Camera: Natus RetCam Envision (130° FOV) · wide-field contact fundus photograph of an infant.
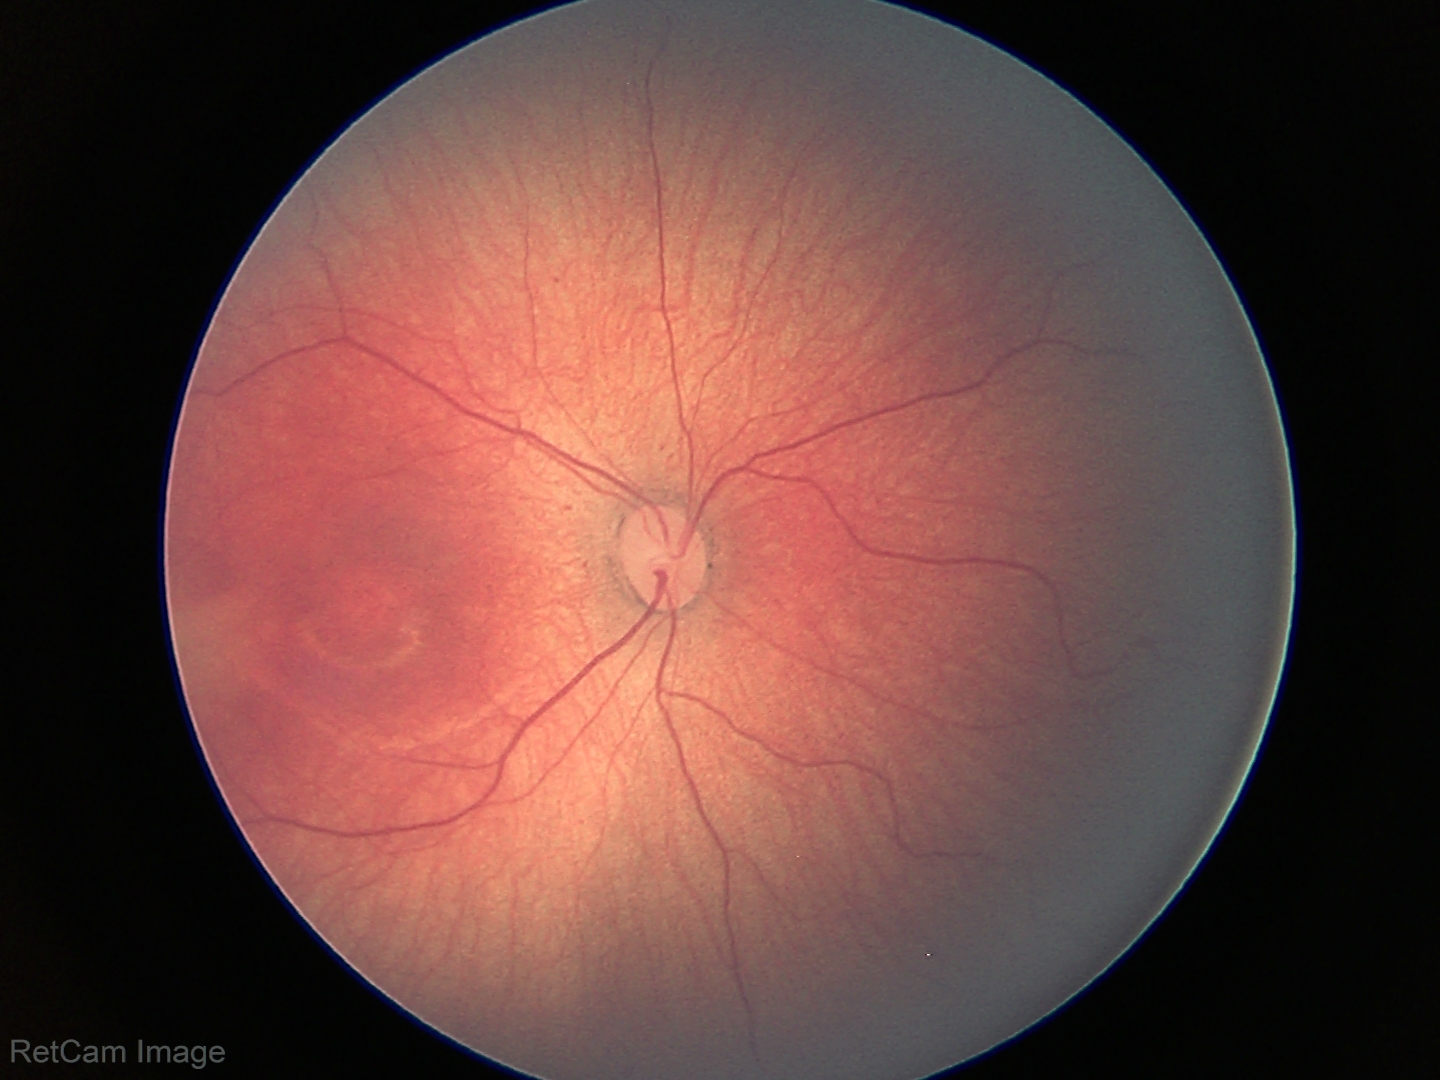 ROP stage = 2.